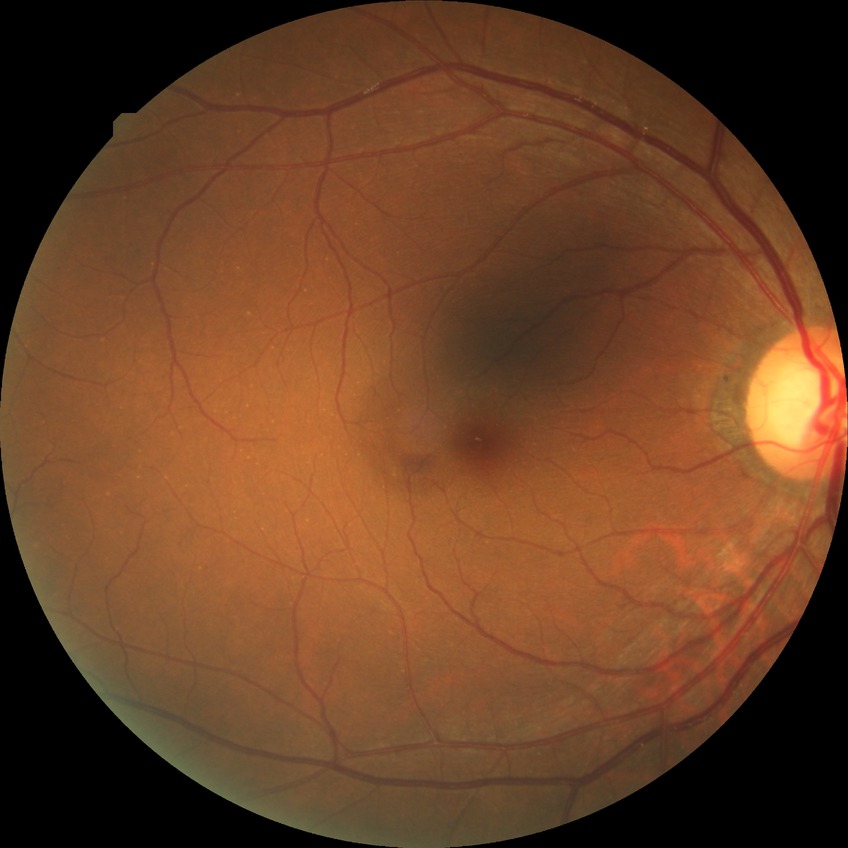 Davis stage is NDR.
No DR findings.